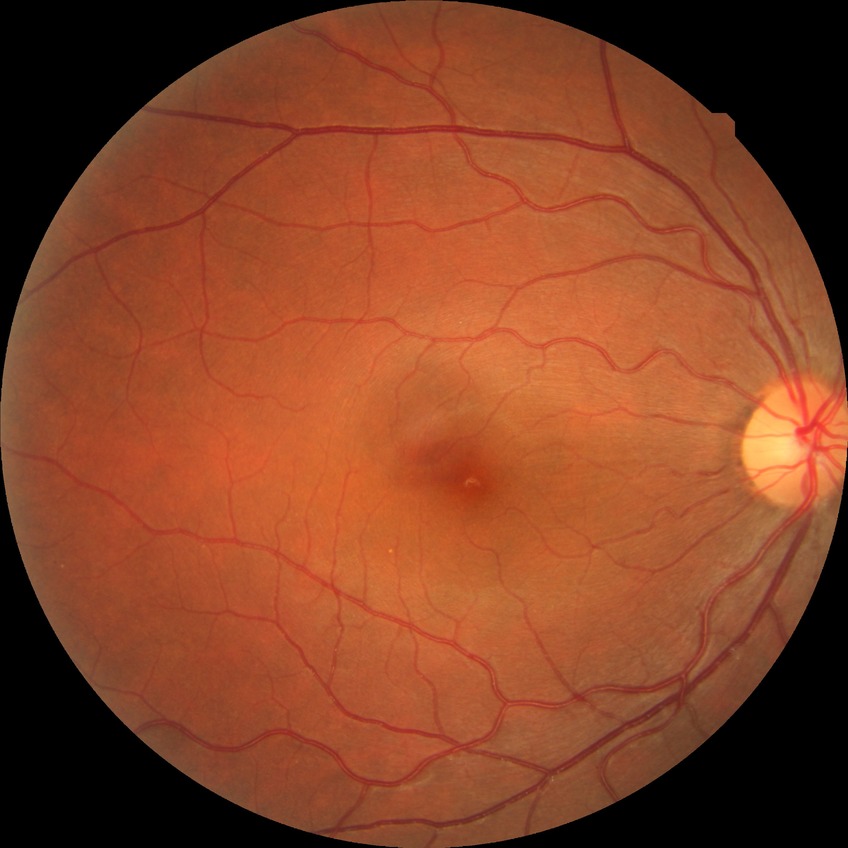
Davis grade is NDR.